Camera: NIDEK AFC-230 · no pharmacologic dilation
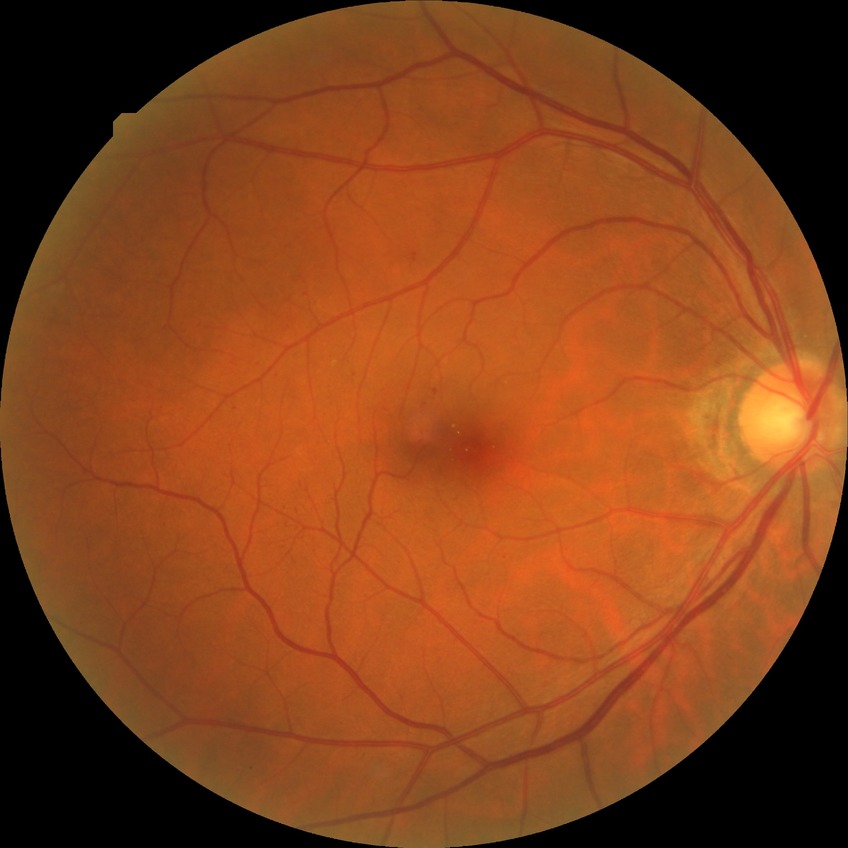

diabetic retinopathy (DR)=simple diabetic retinopathy (SDR).